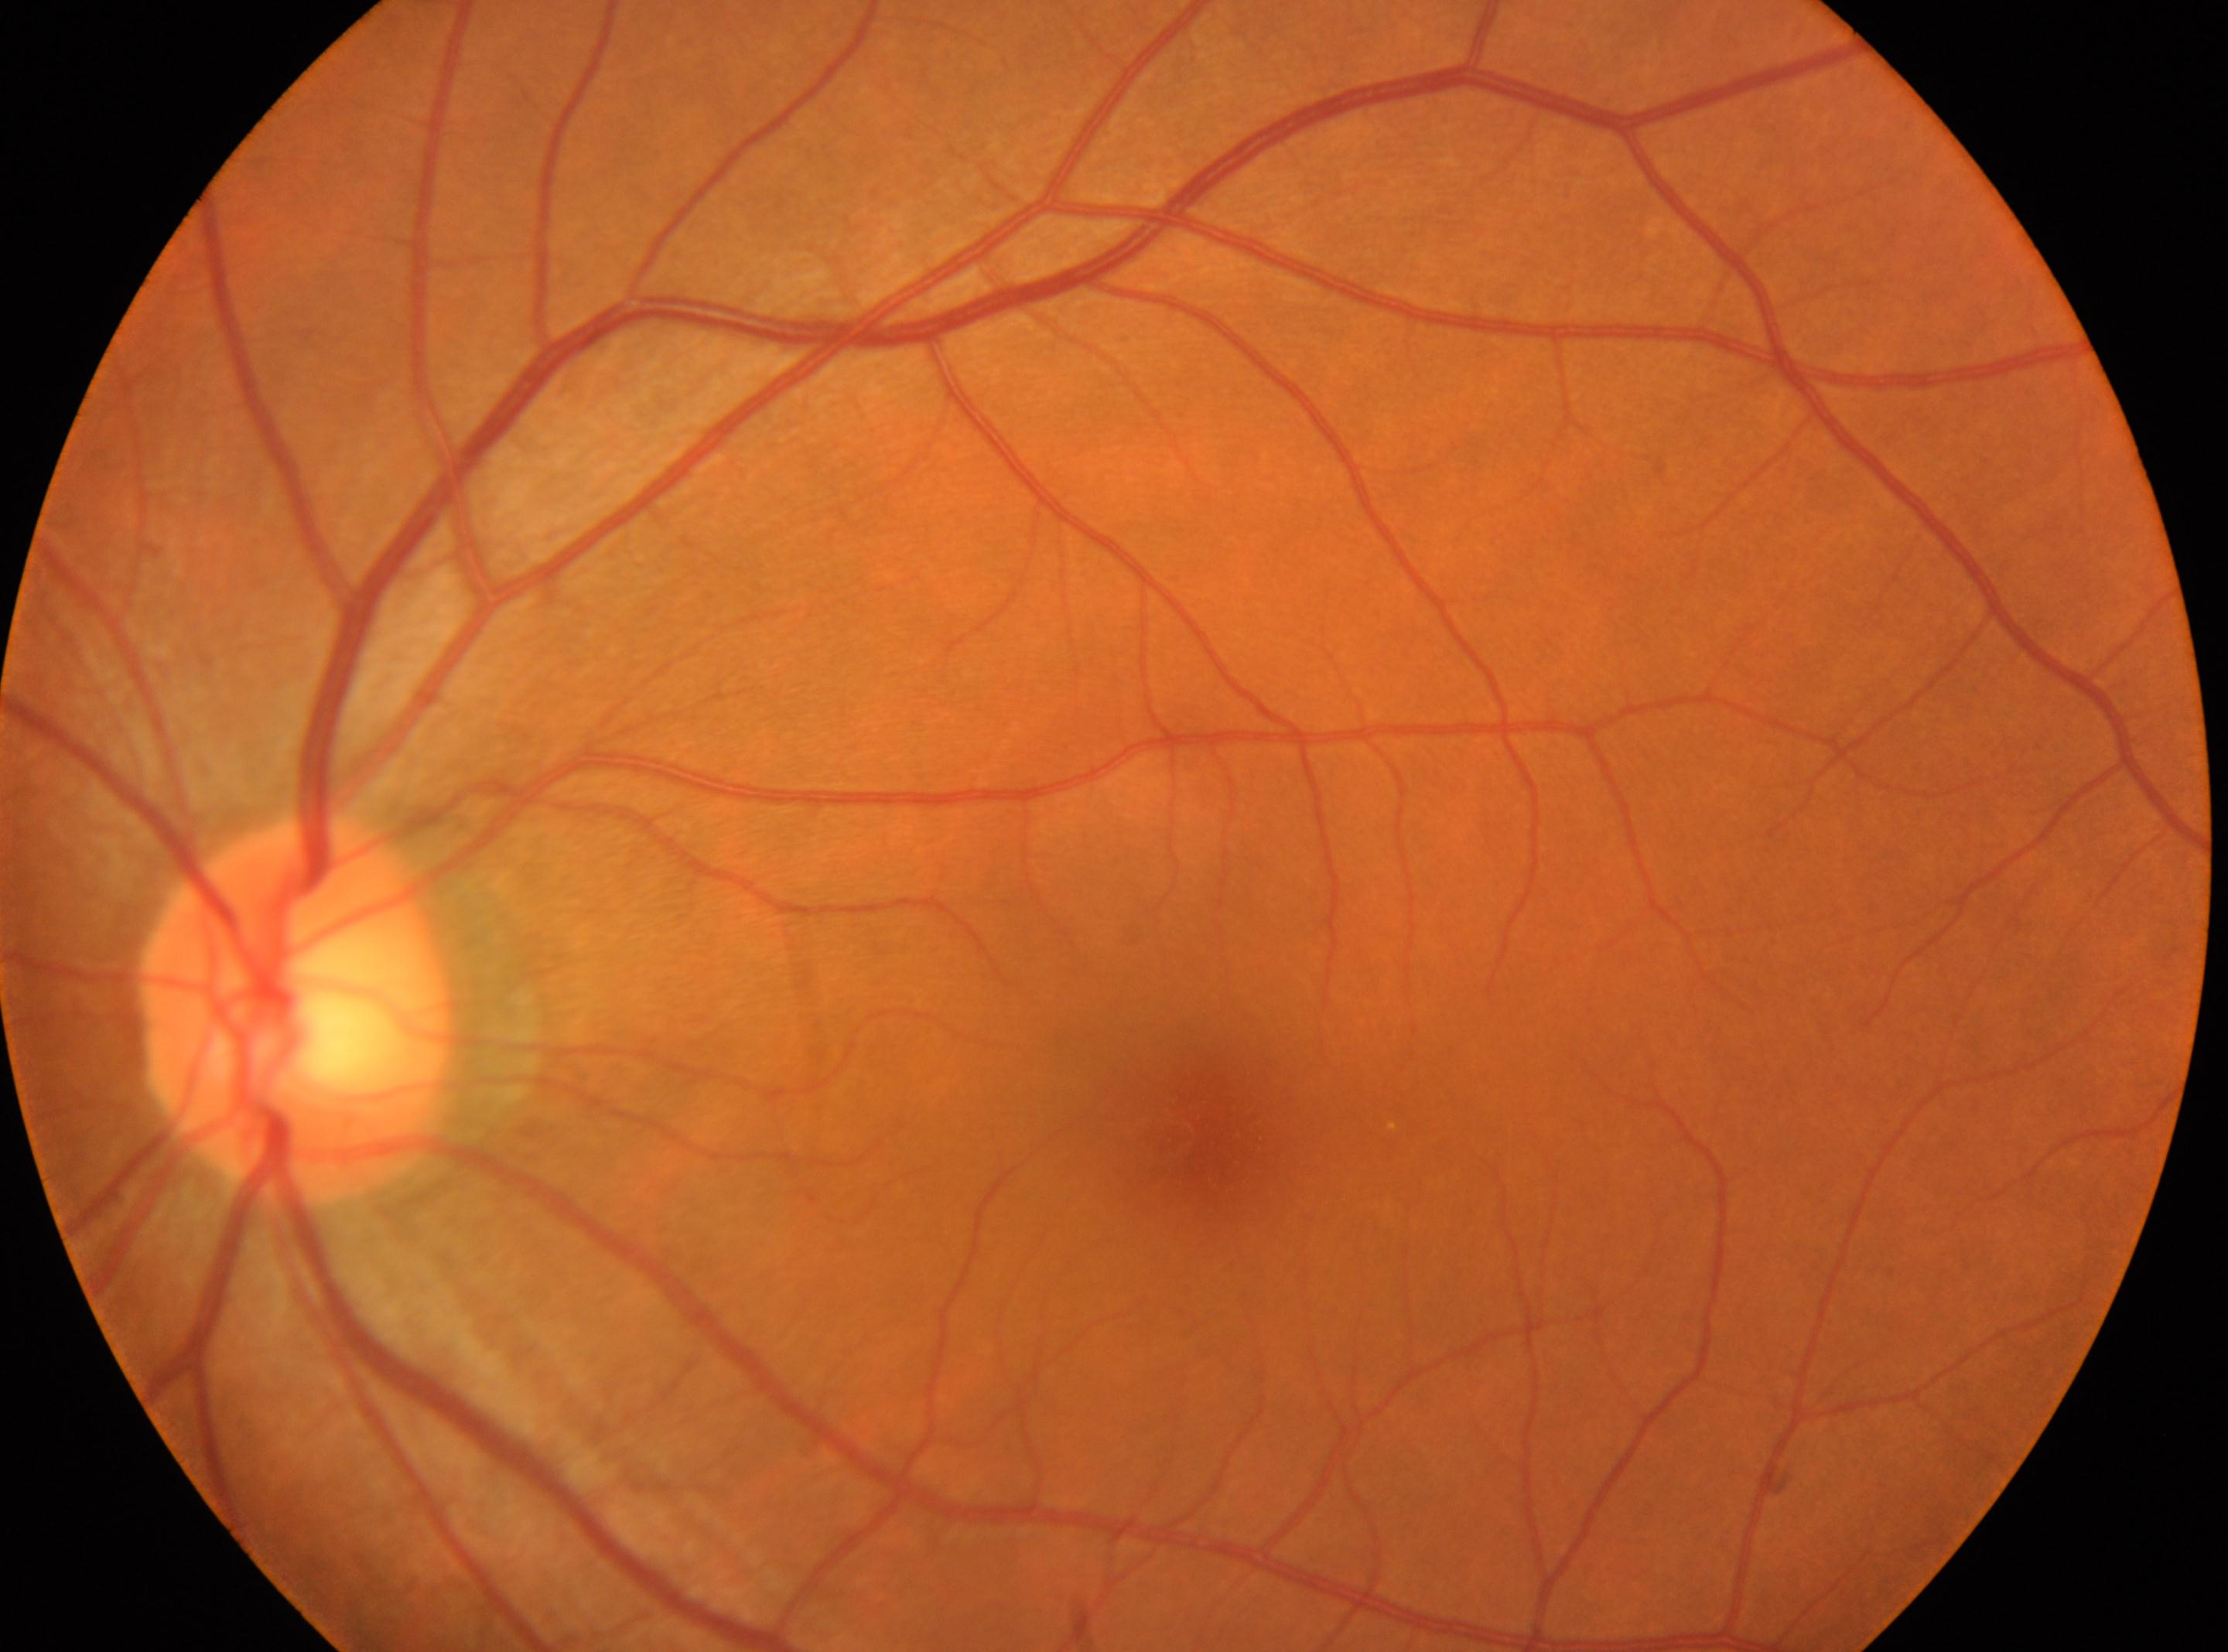
Findings:
* DR stage — no apparent diabetic retinopathy (grade 0)
* laterality — oculus sinister
* optic disc — (296,1007)
* foveal center — (1184,1128)